Pediatric retinal photograph (wide-field); 1440 by 1080 pixels.
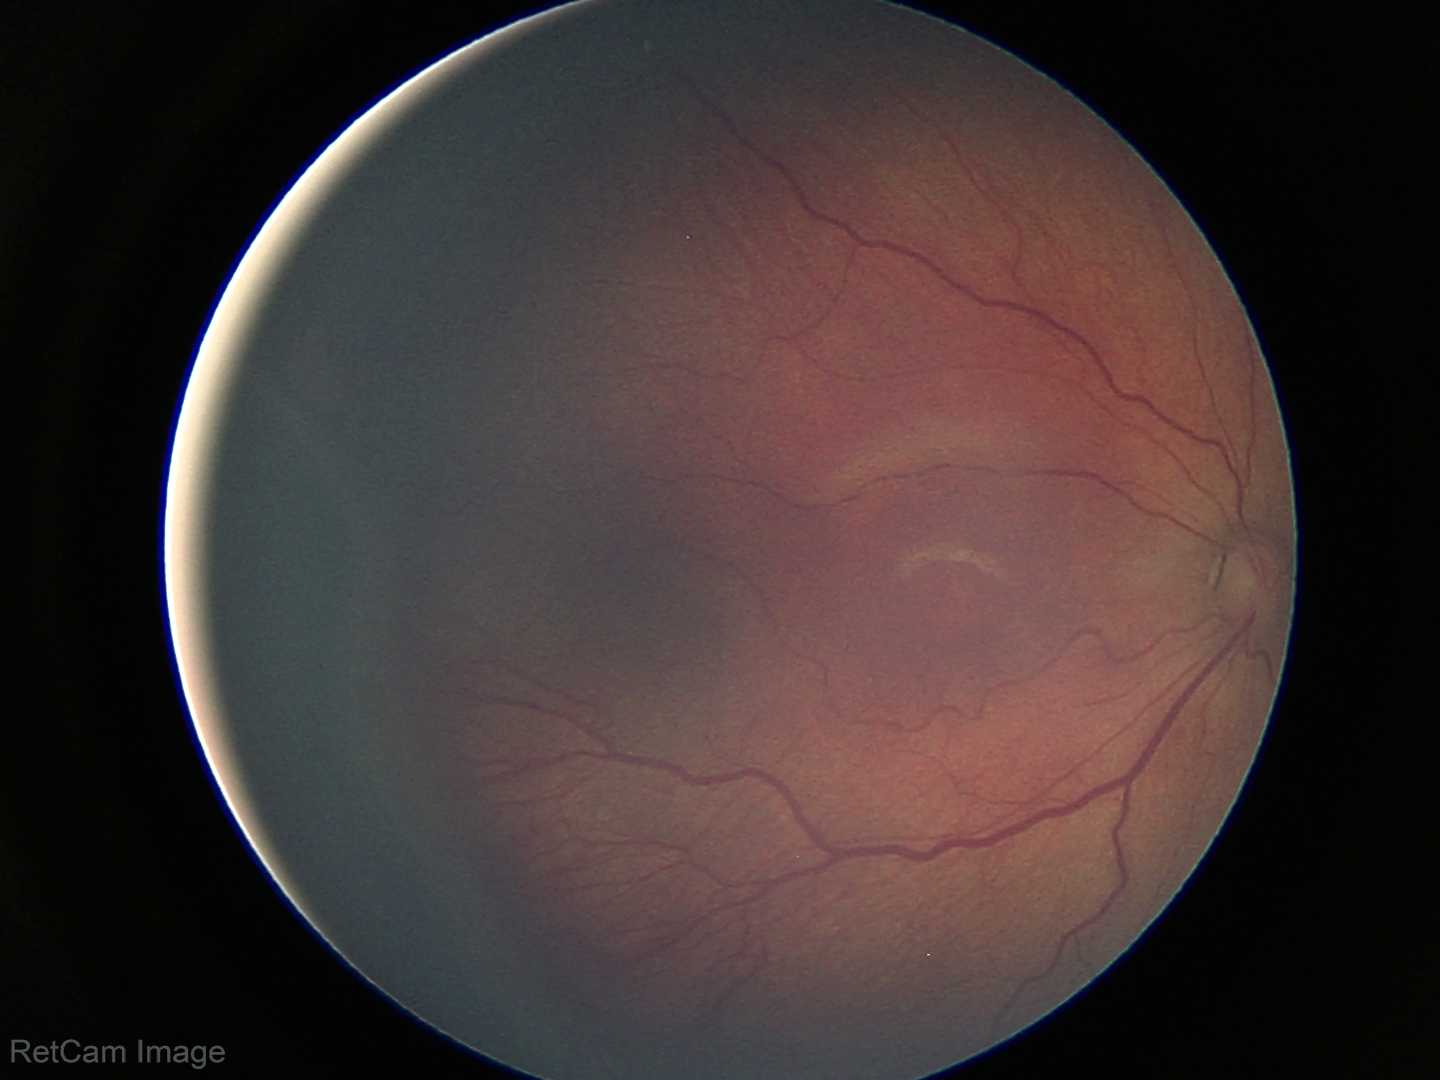

Without plus disease.
Screening series with retinopathy of prematurity (ROP) stage 3.